Fundus photo
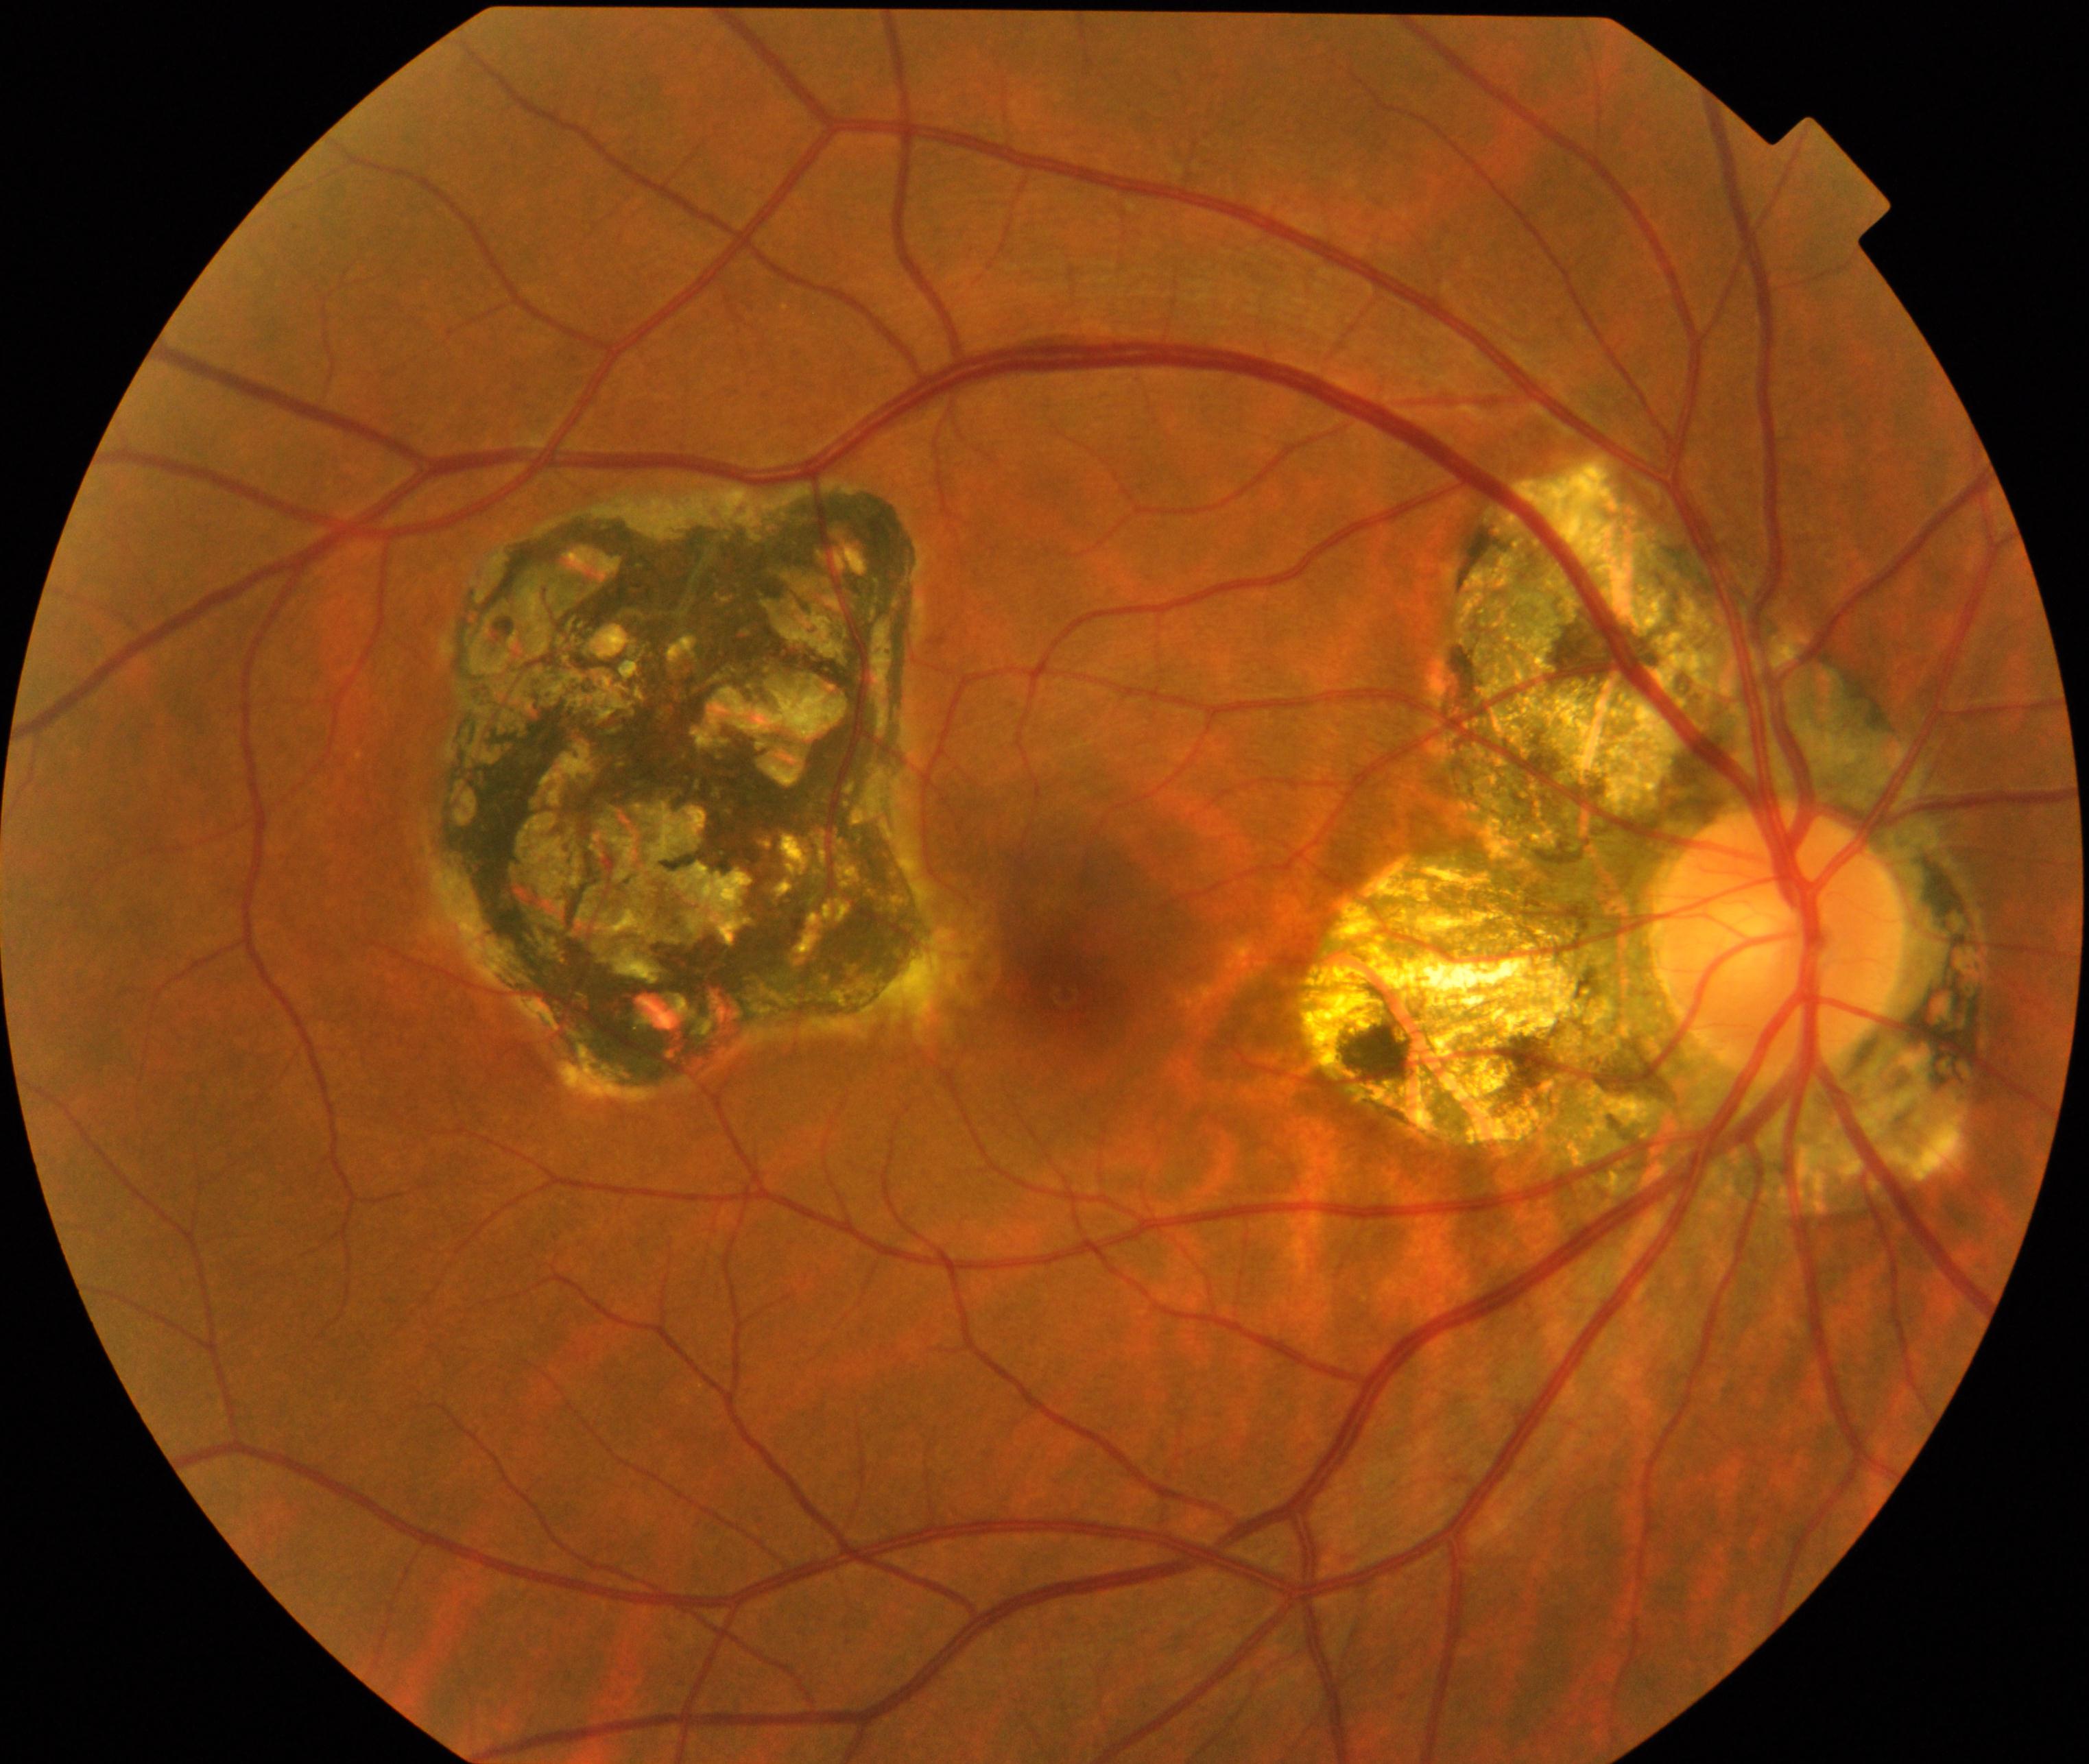 Primary finding: chorioretinal atrophy or coloboma.